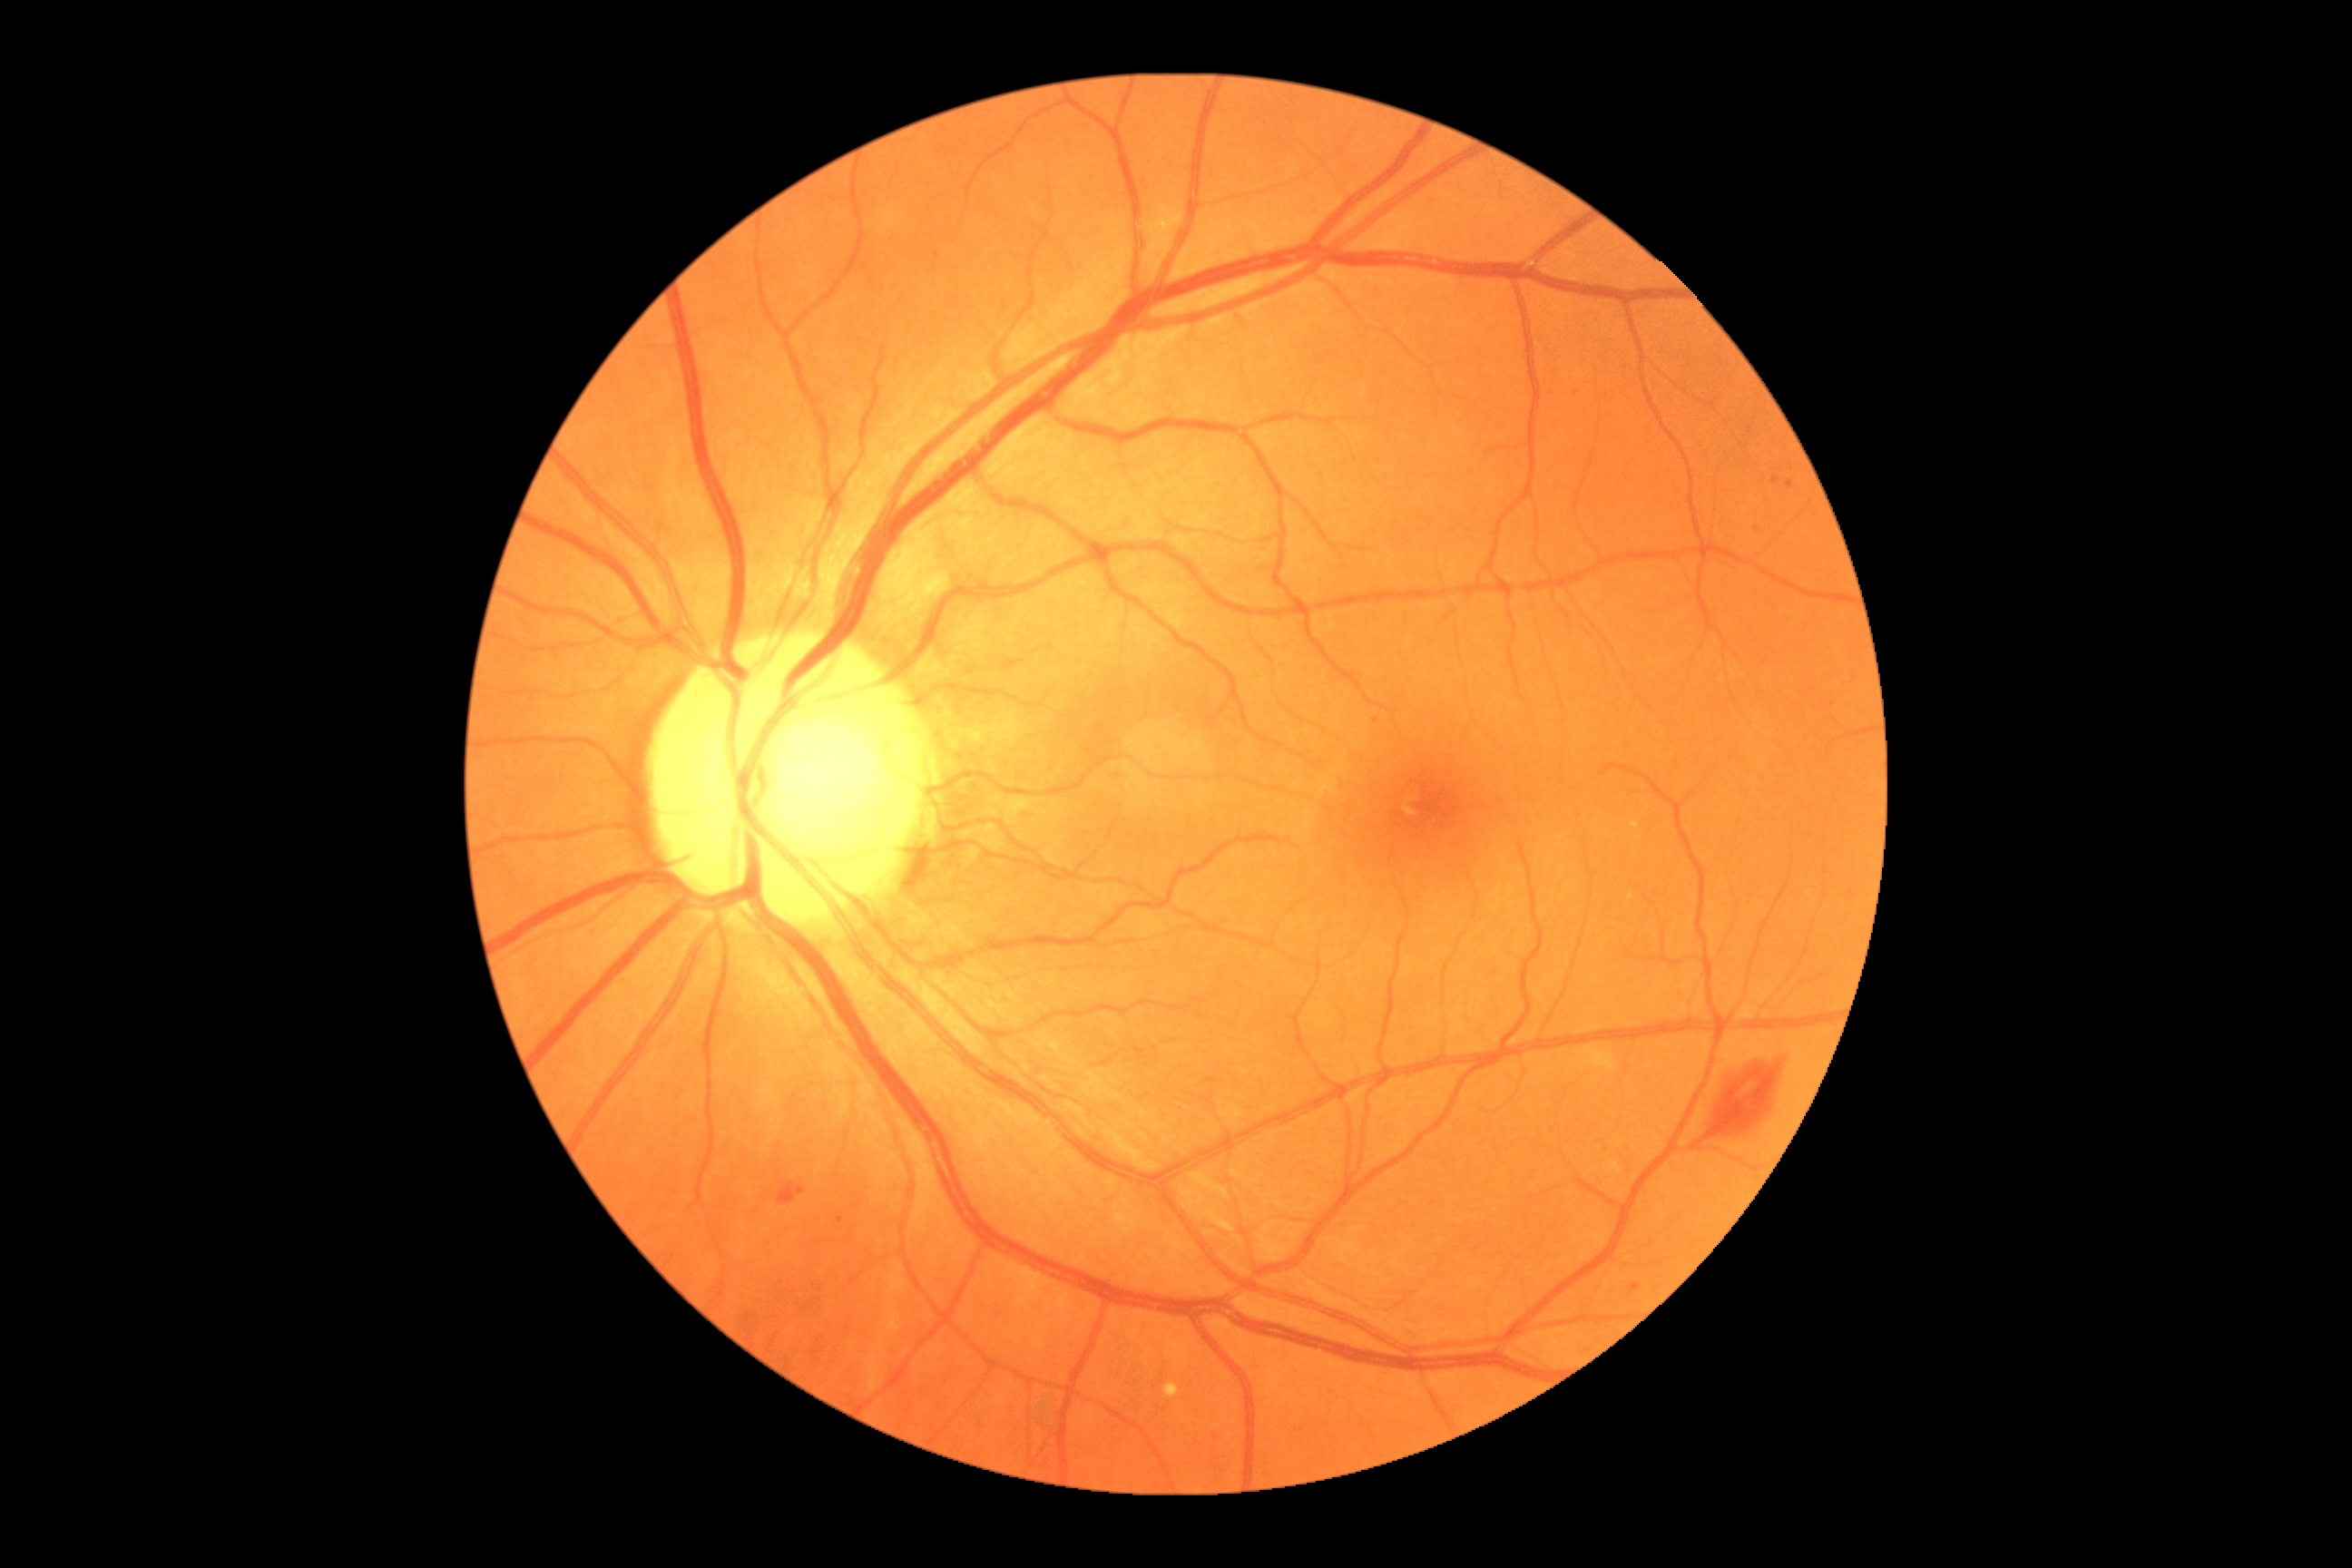 DR stage: 2. Disease class: non-proliferative diabetic retinopathy.